1470 by 1137 pixels — 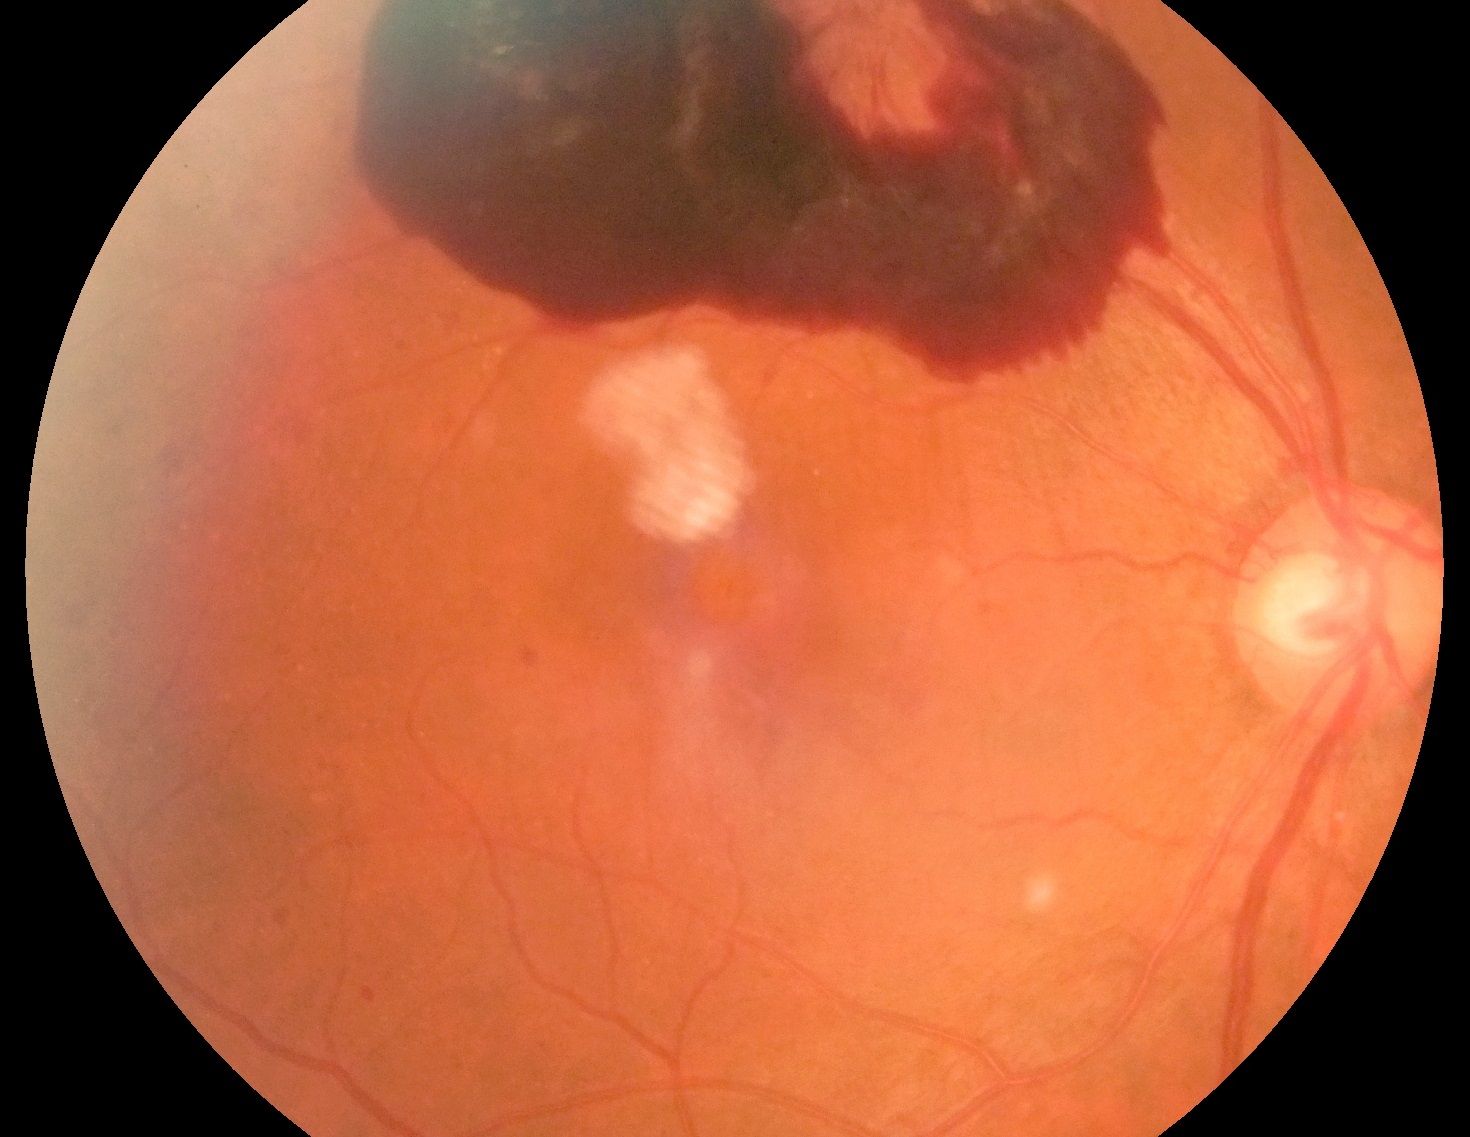
Annotations:
• diabetic retinopathy grade: PDR (4)